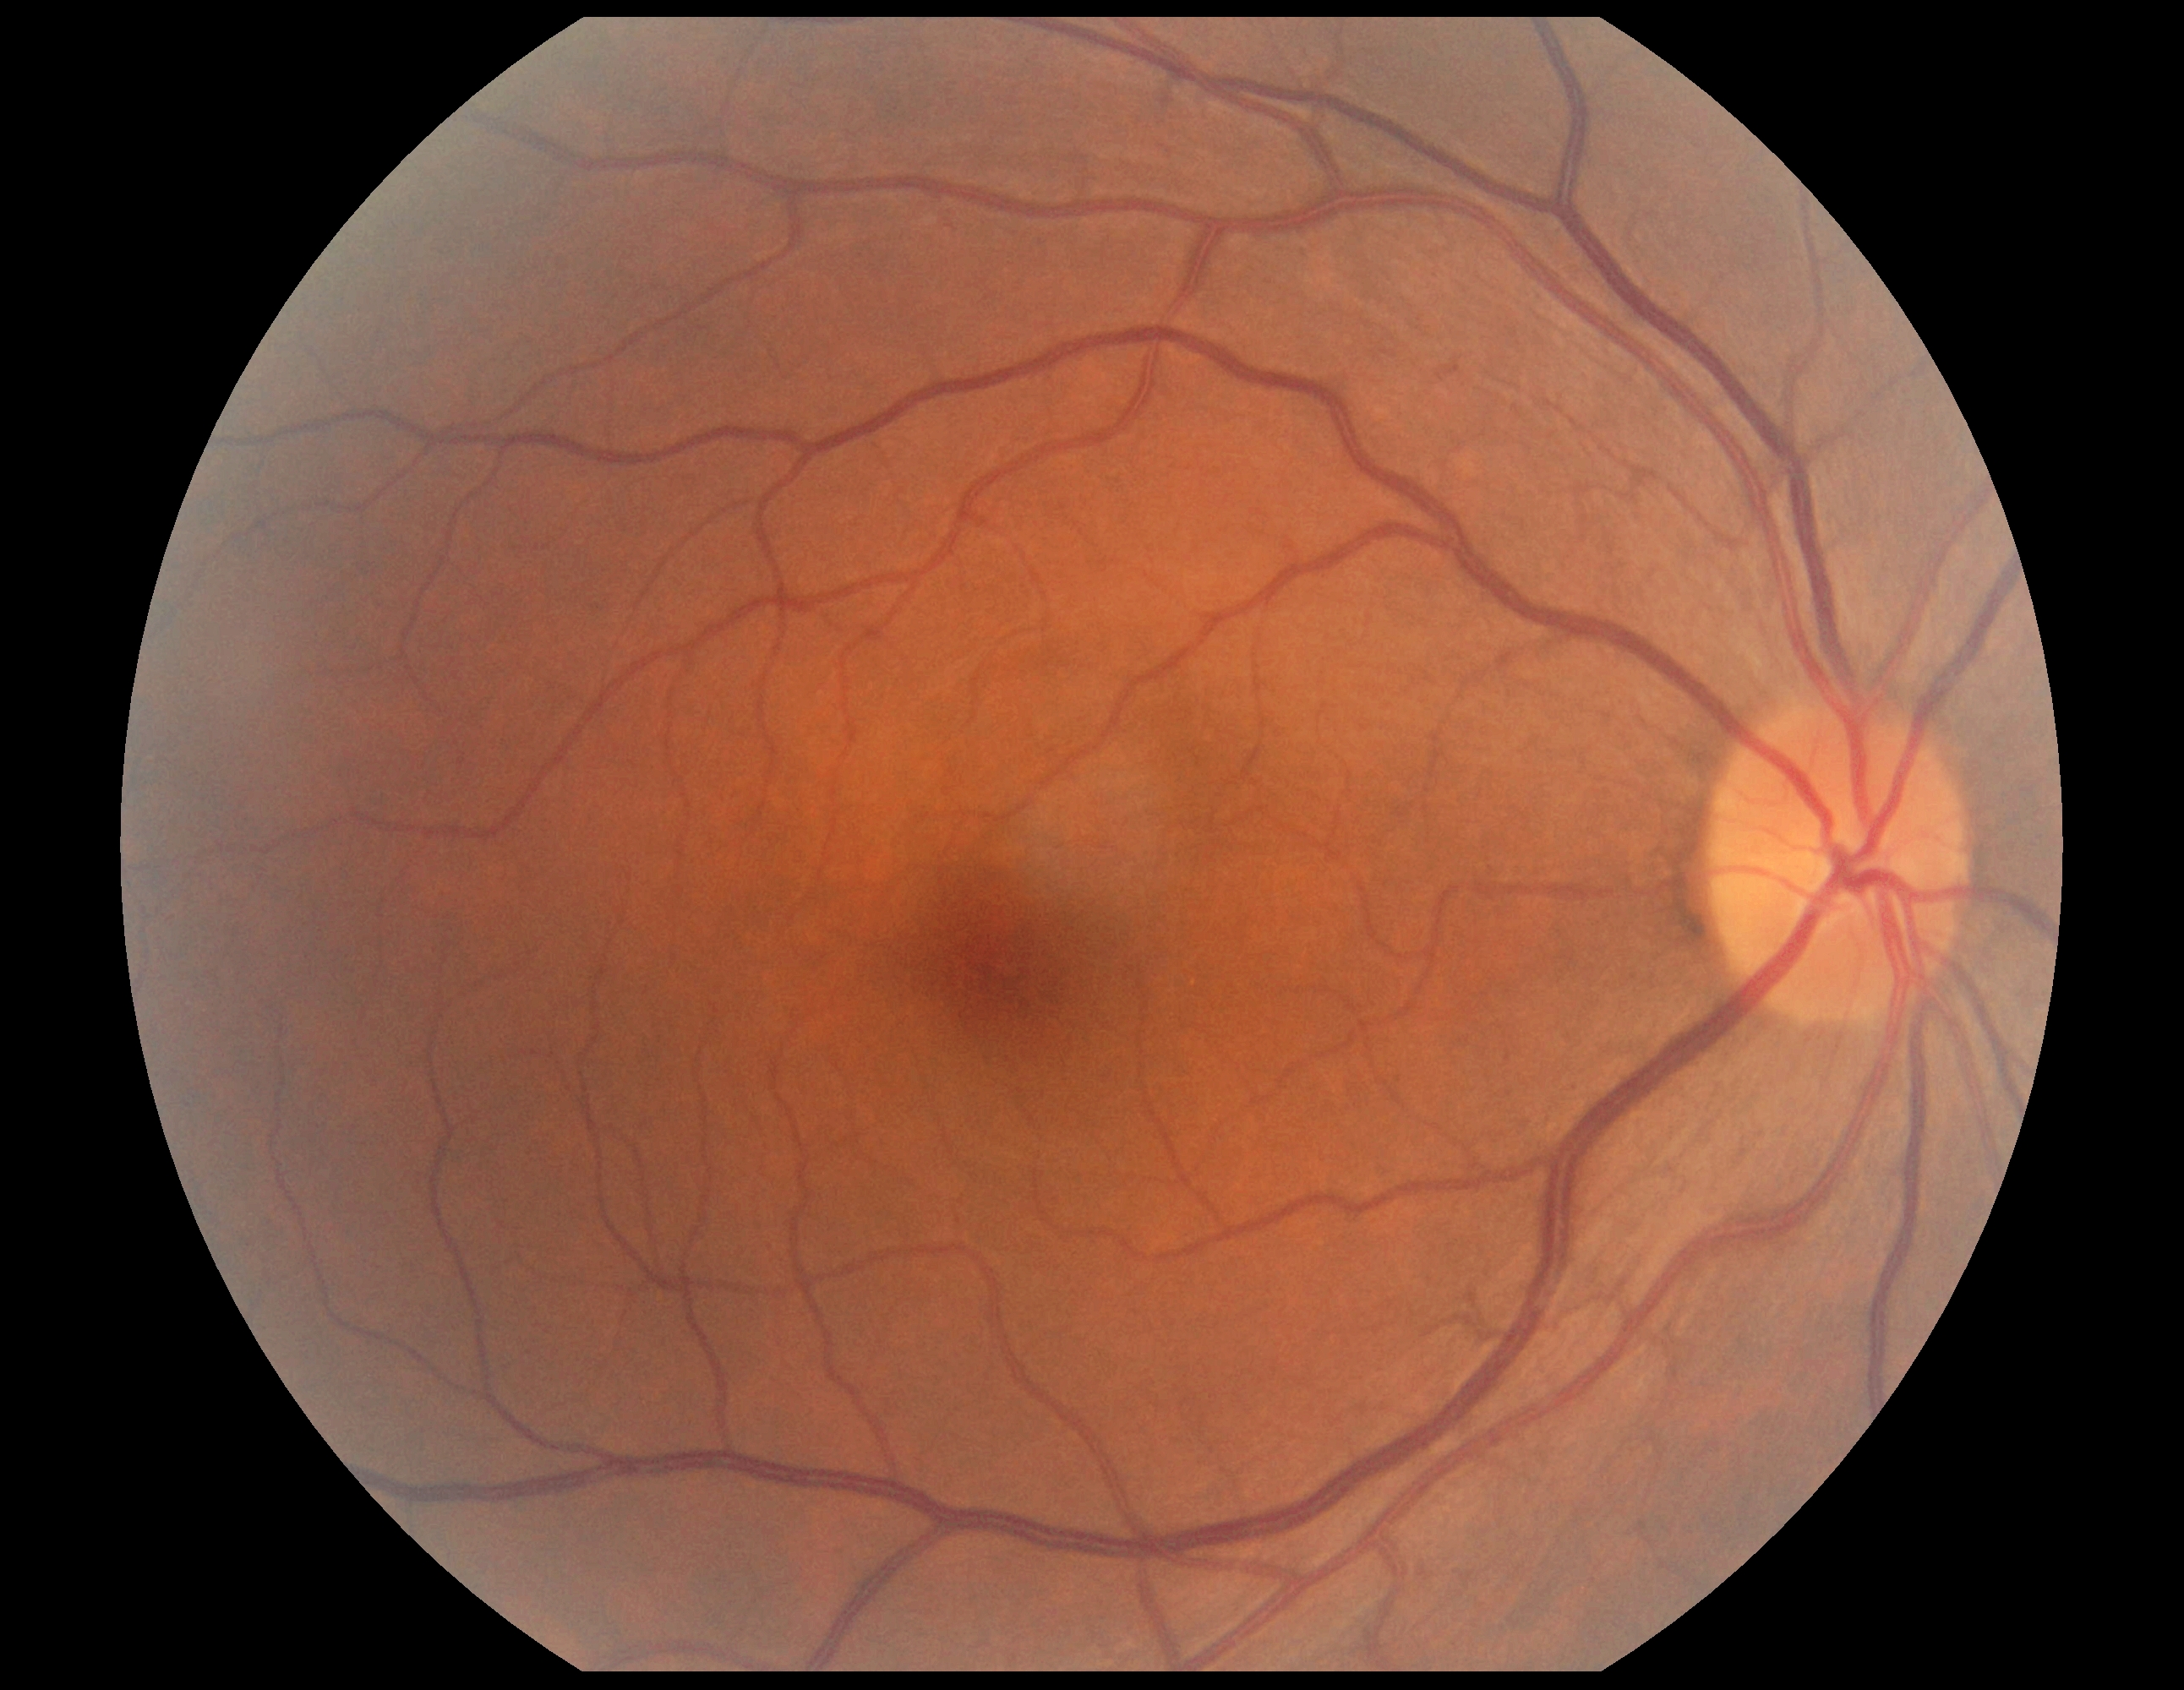
DR severity: grade 0 (no apparent retinopathy).
No signs of diabetic retinopathy.